Modified Davis grading
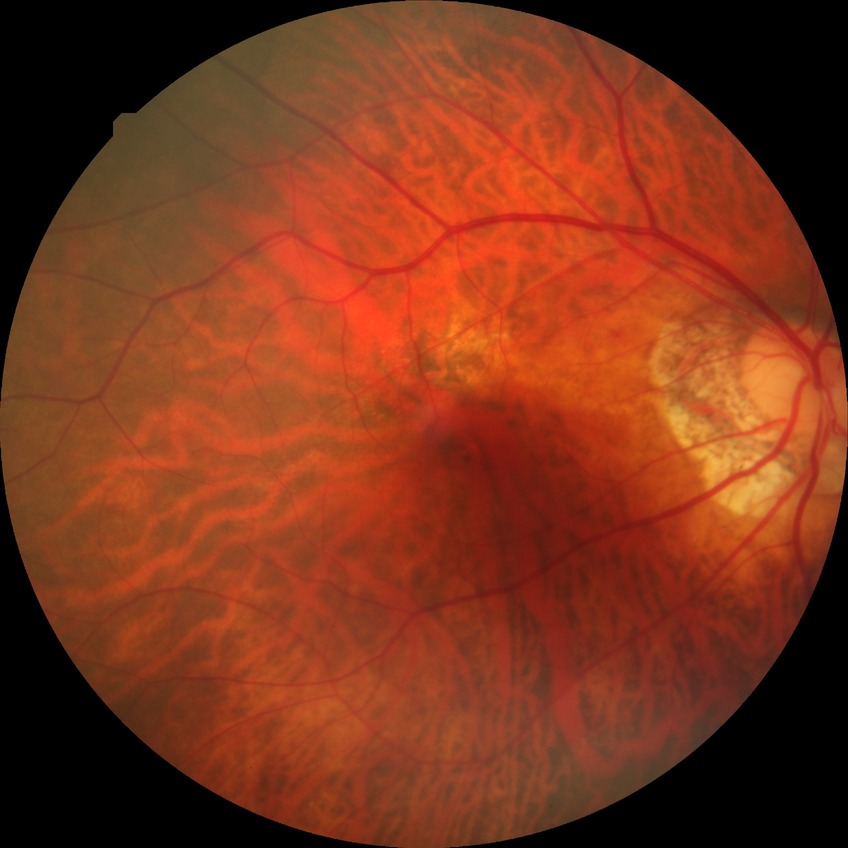

{"davis_grade": "NDR (no diabetic retinopathy)"}